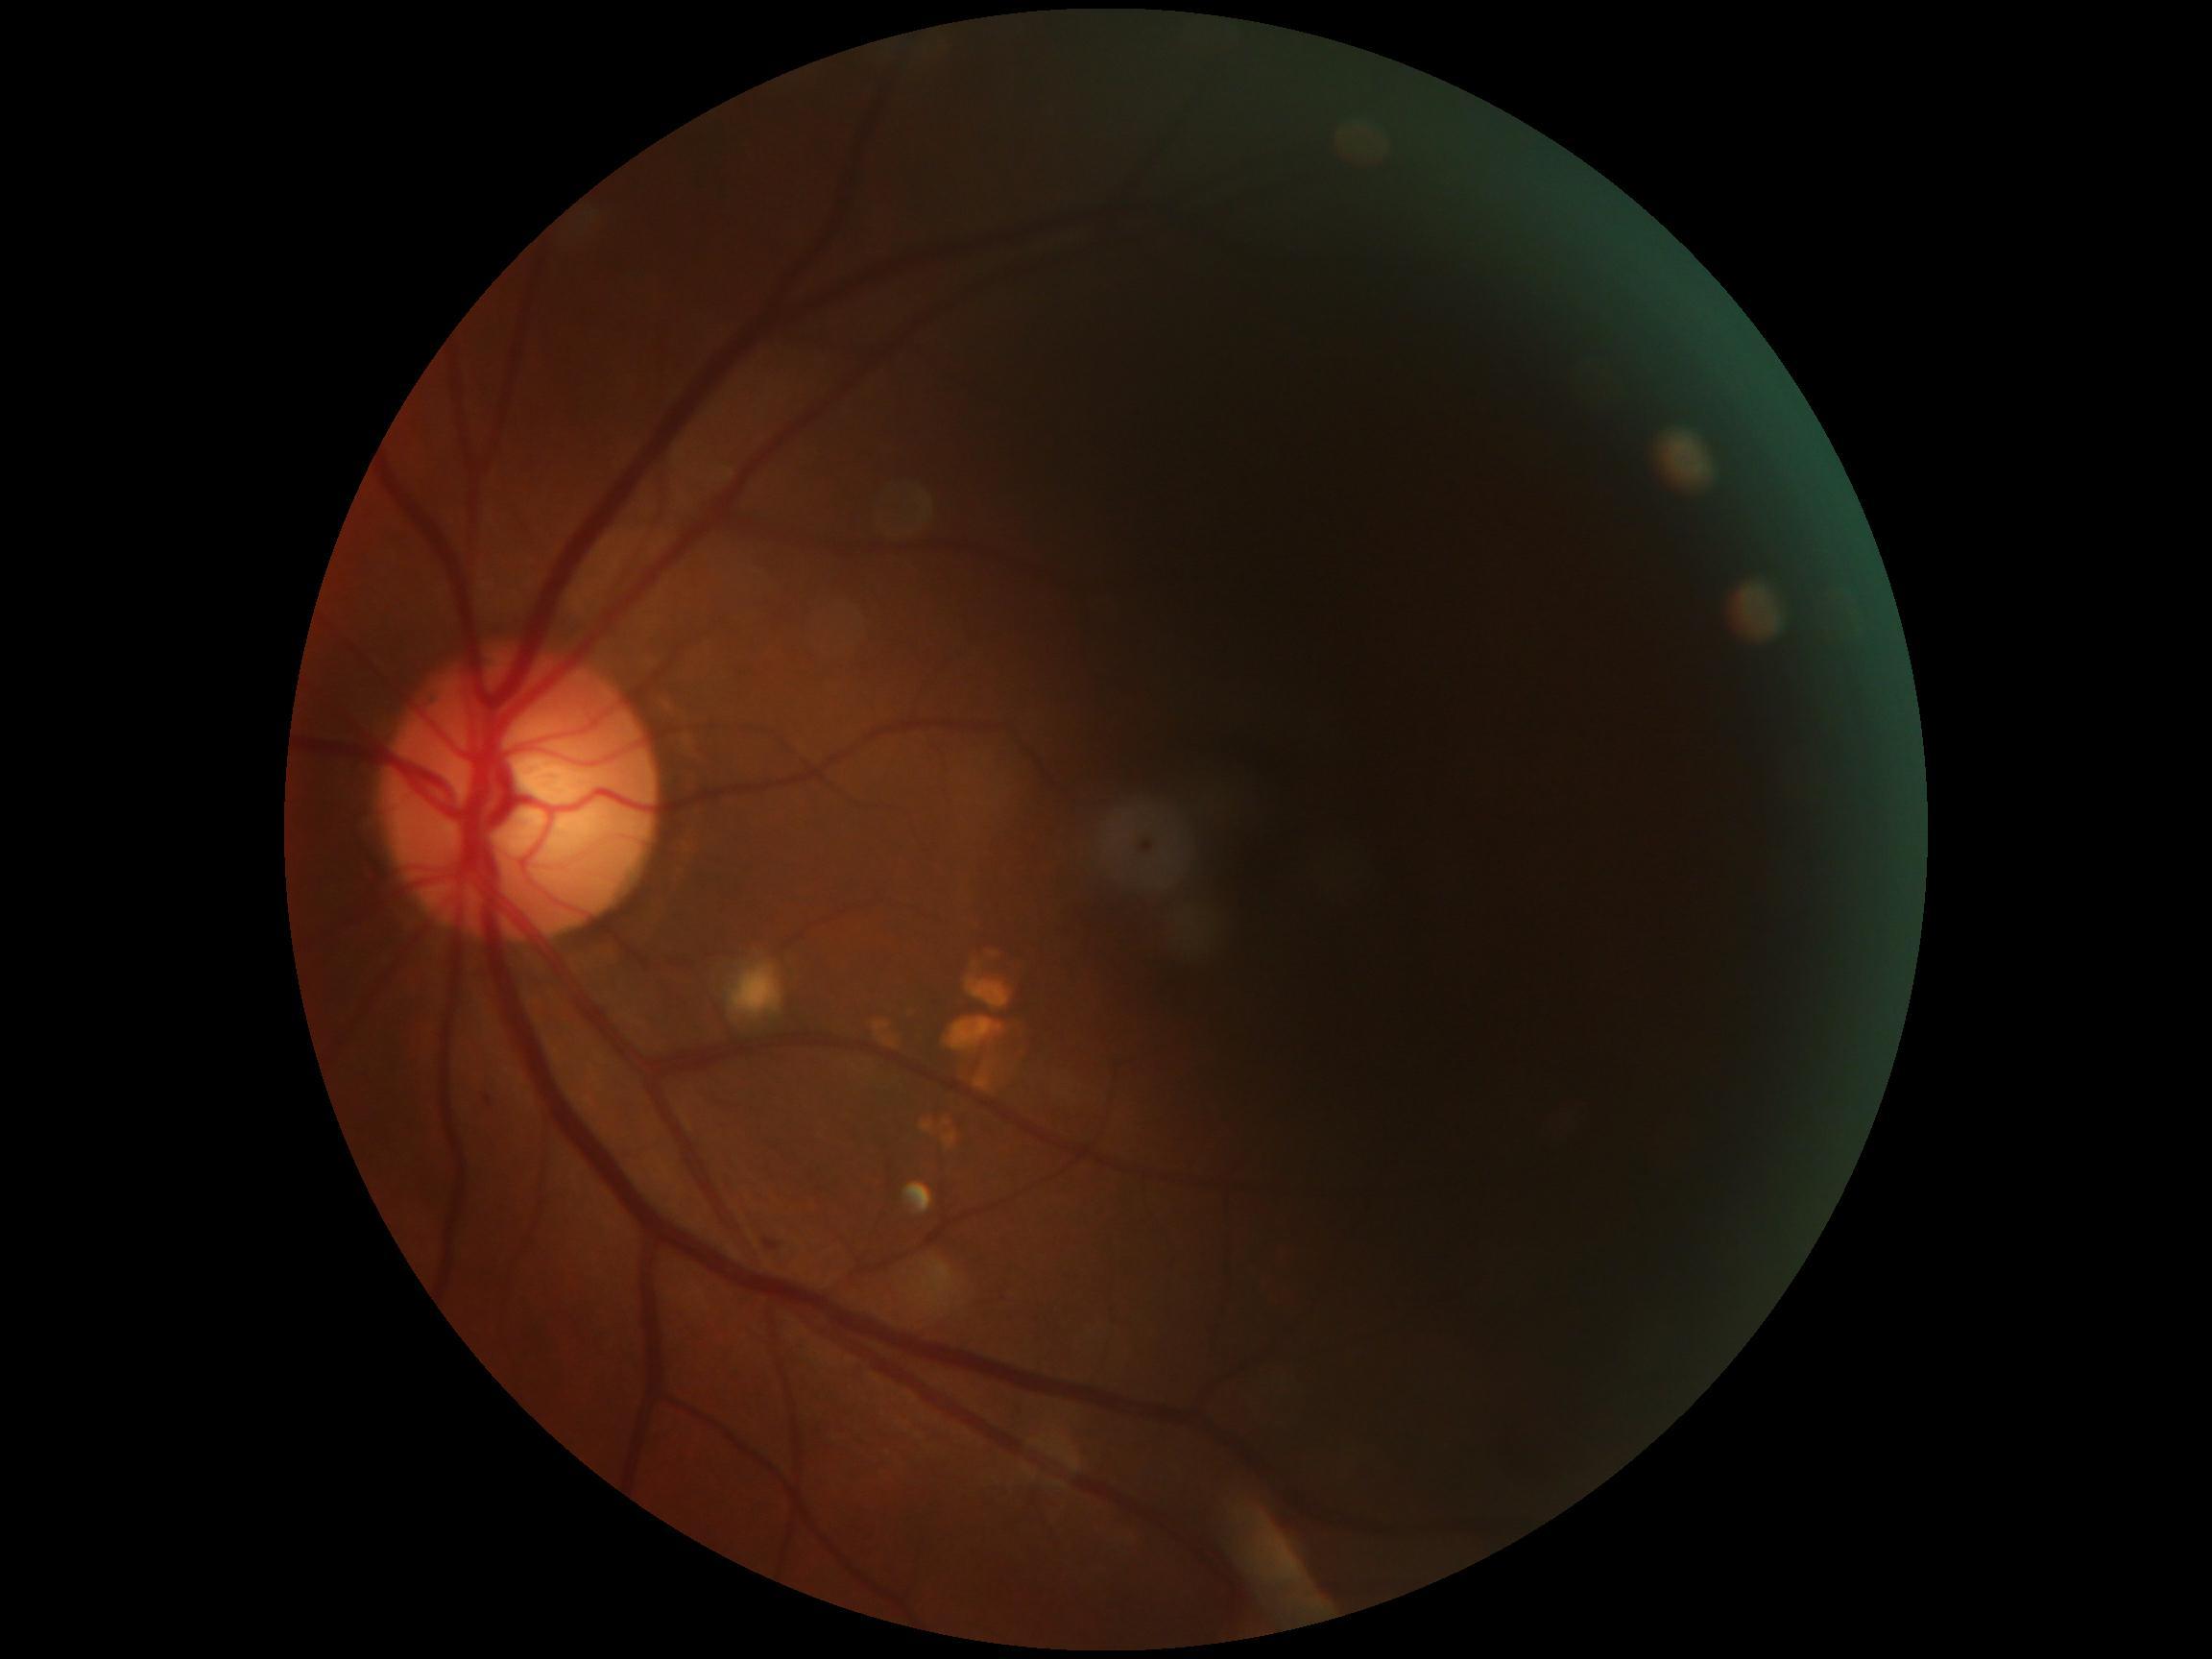 {
  "dr_grade": "grade 2"
}